Wide-field fundus photograph from neonatal ROP screening; image size 1240x1240:
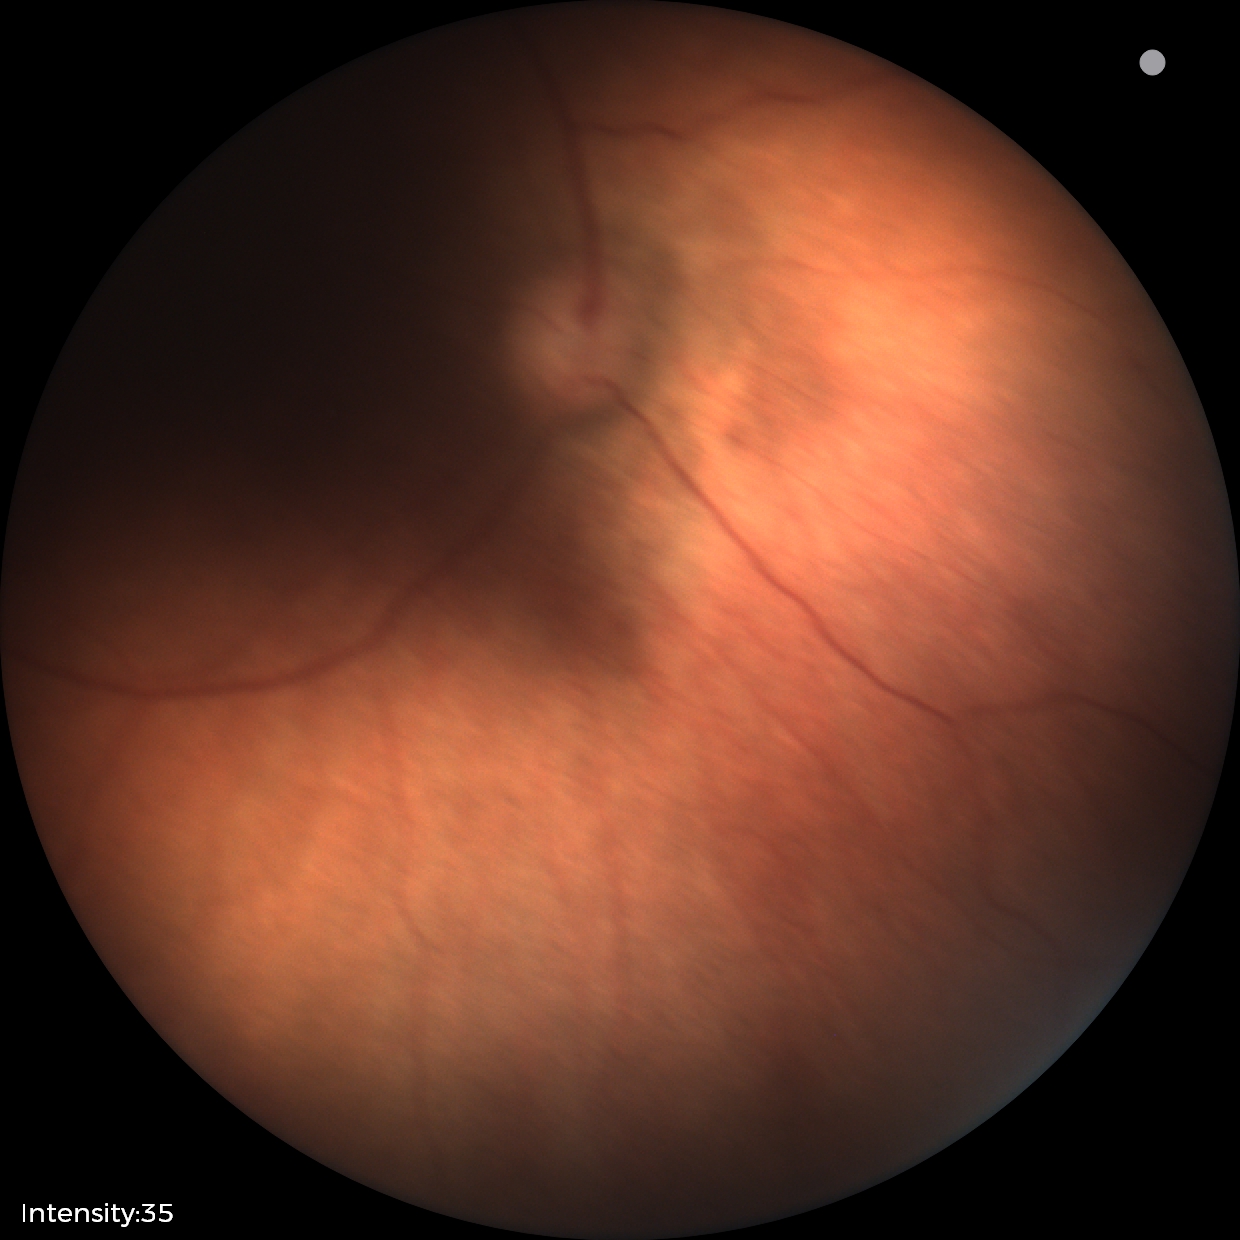

Normal screening examination.